2048x1536. 45° field of view — 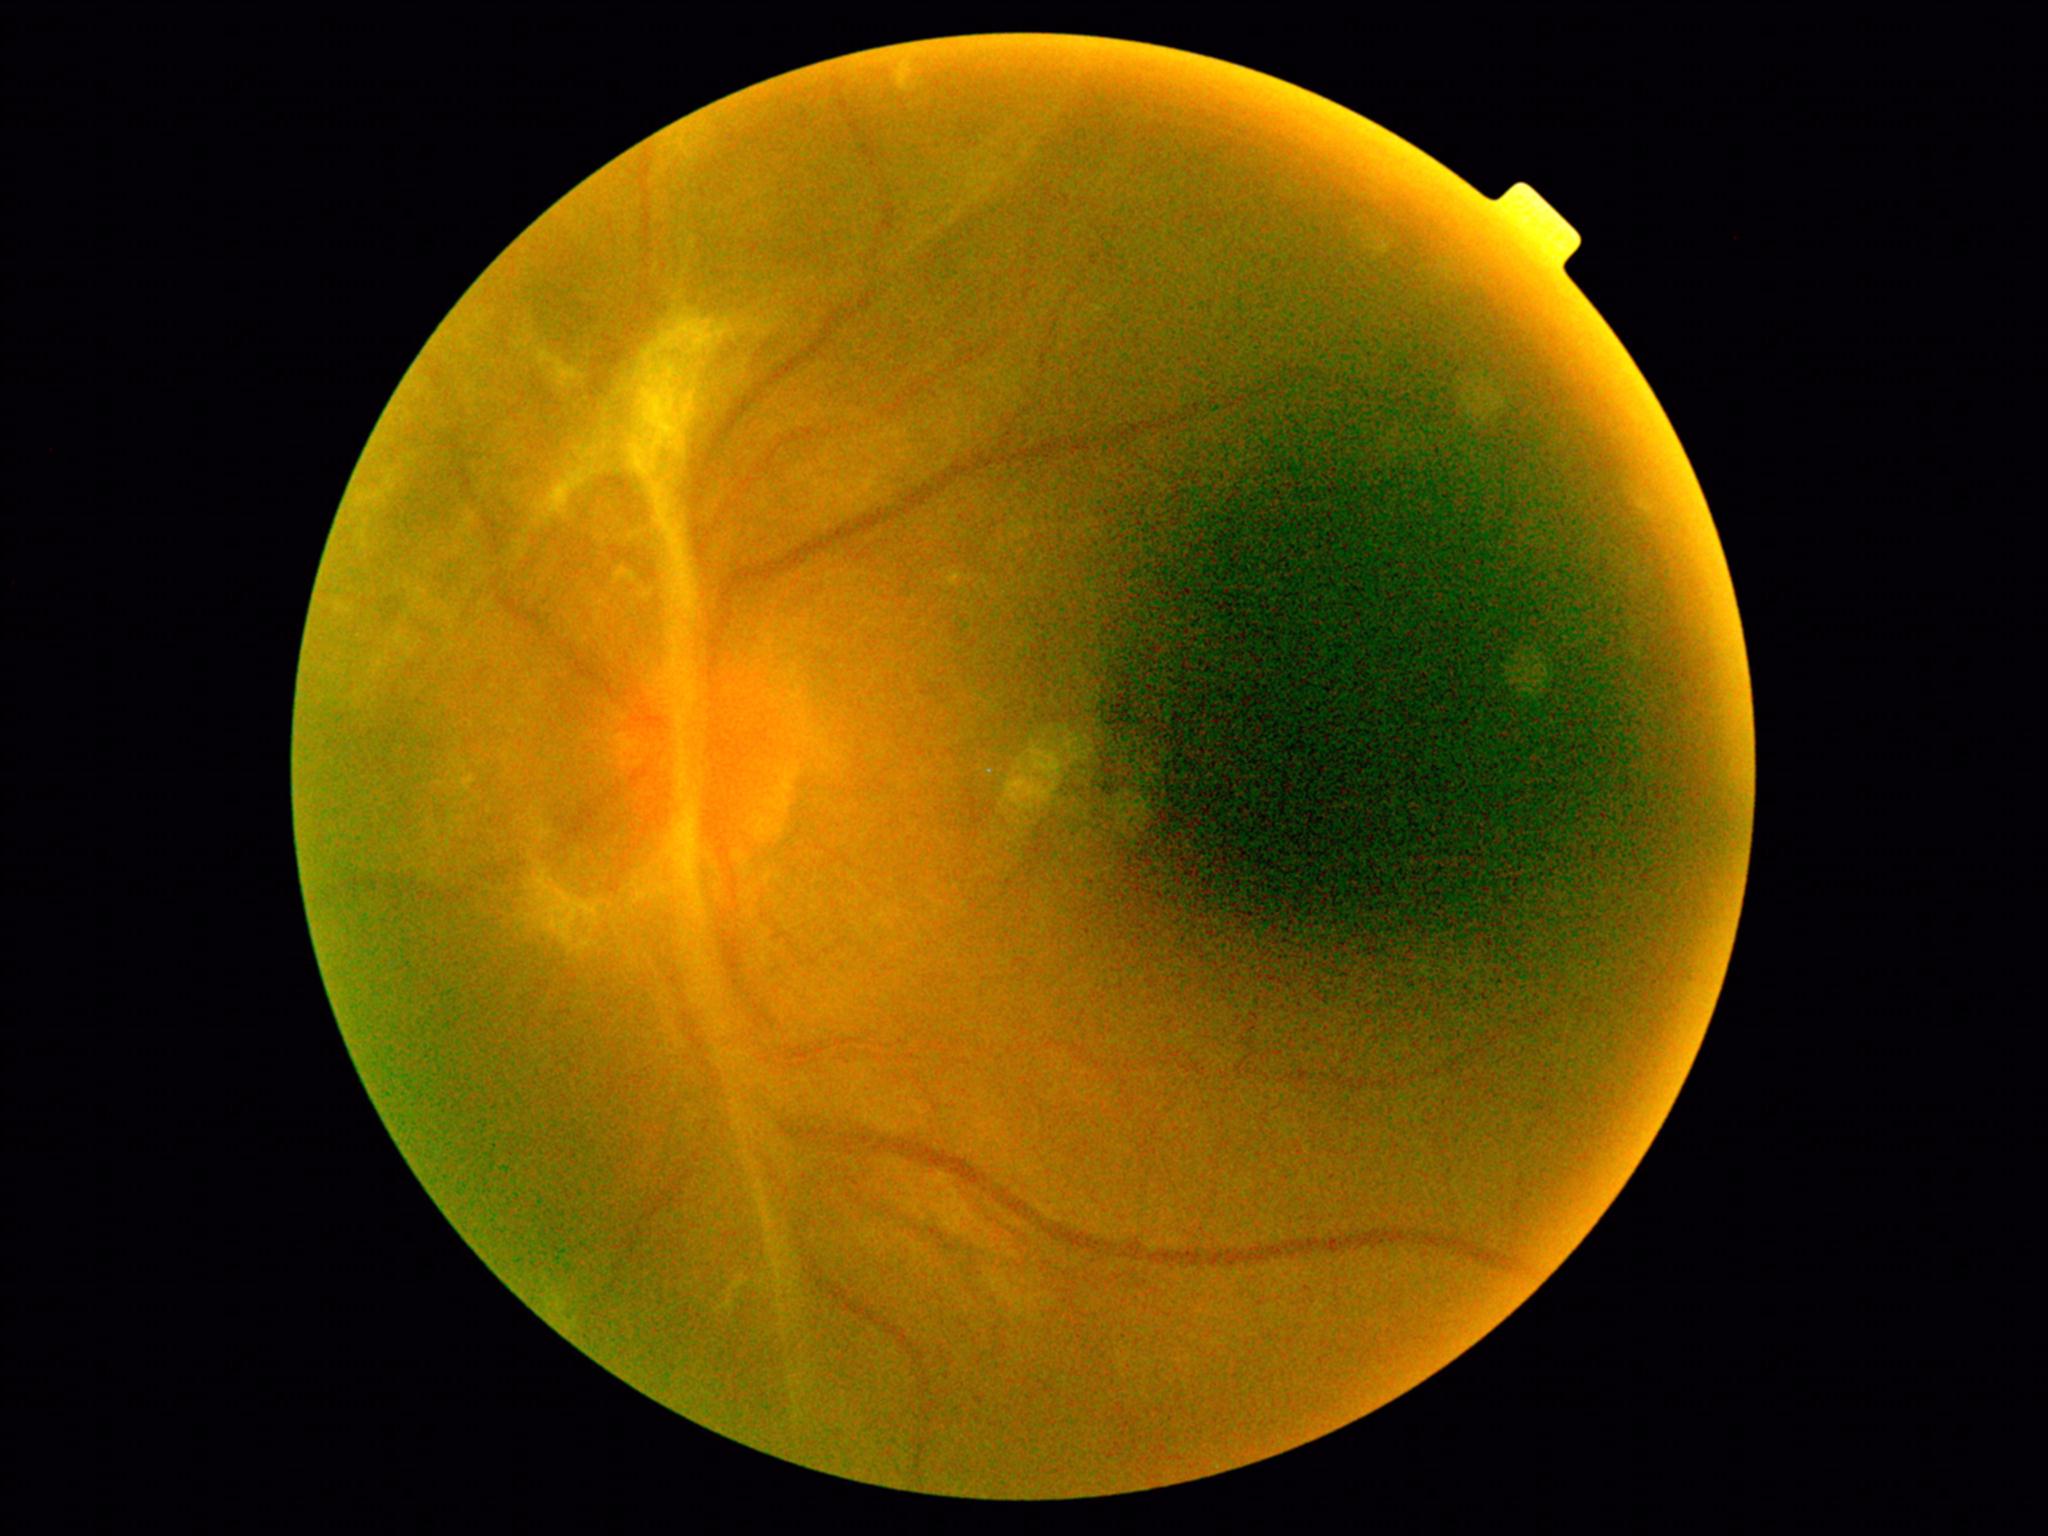

DR stage@grade 4.